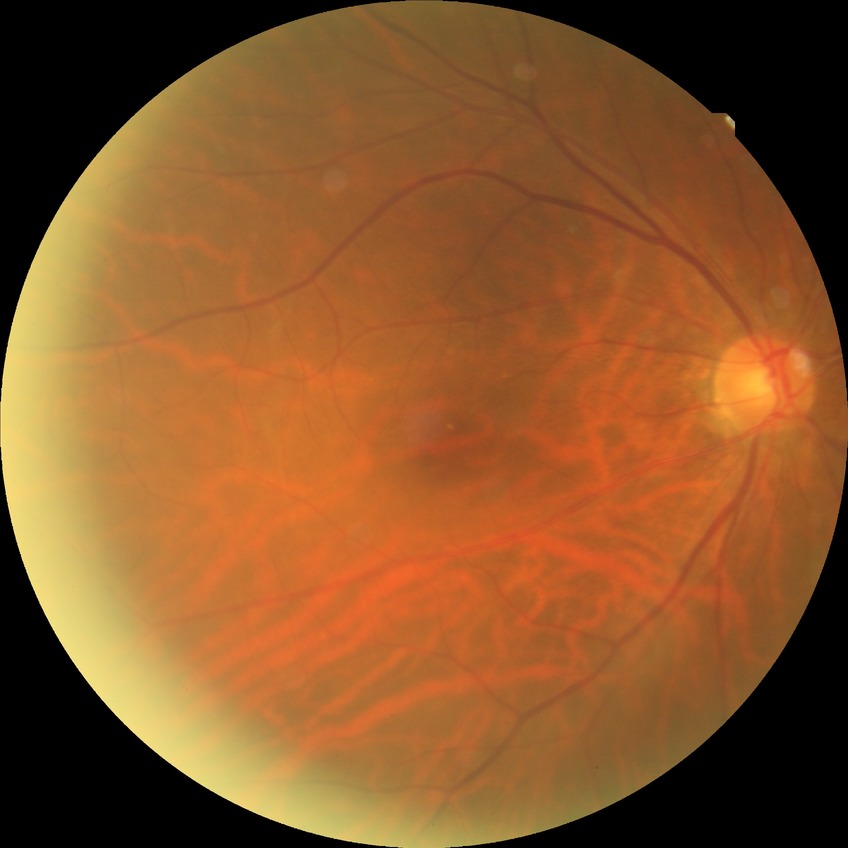
modified Davis classification = no diabetic retinopathy